Captured with the Clarity RetCam 3 (130° field of view) · pediatric retinal photograph (wide-field) — 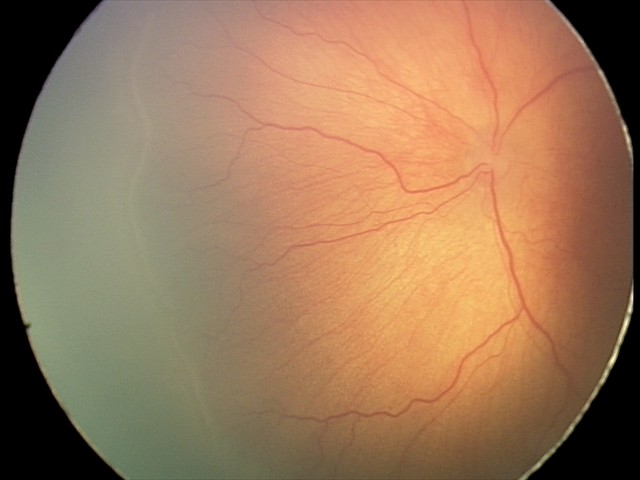 Examination diagnosed as retinopathy of prematurity stage 1.
Without plus disease.